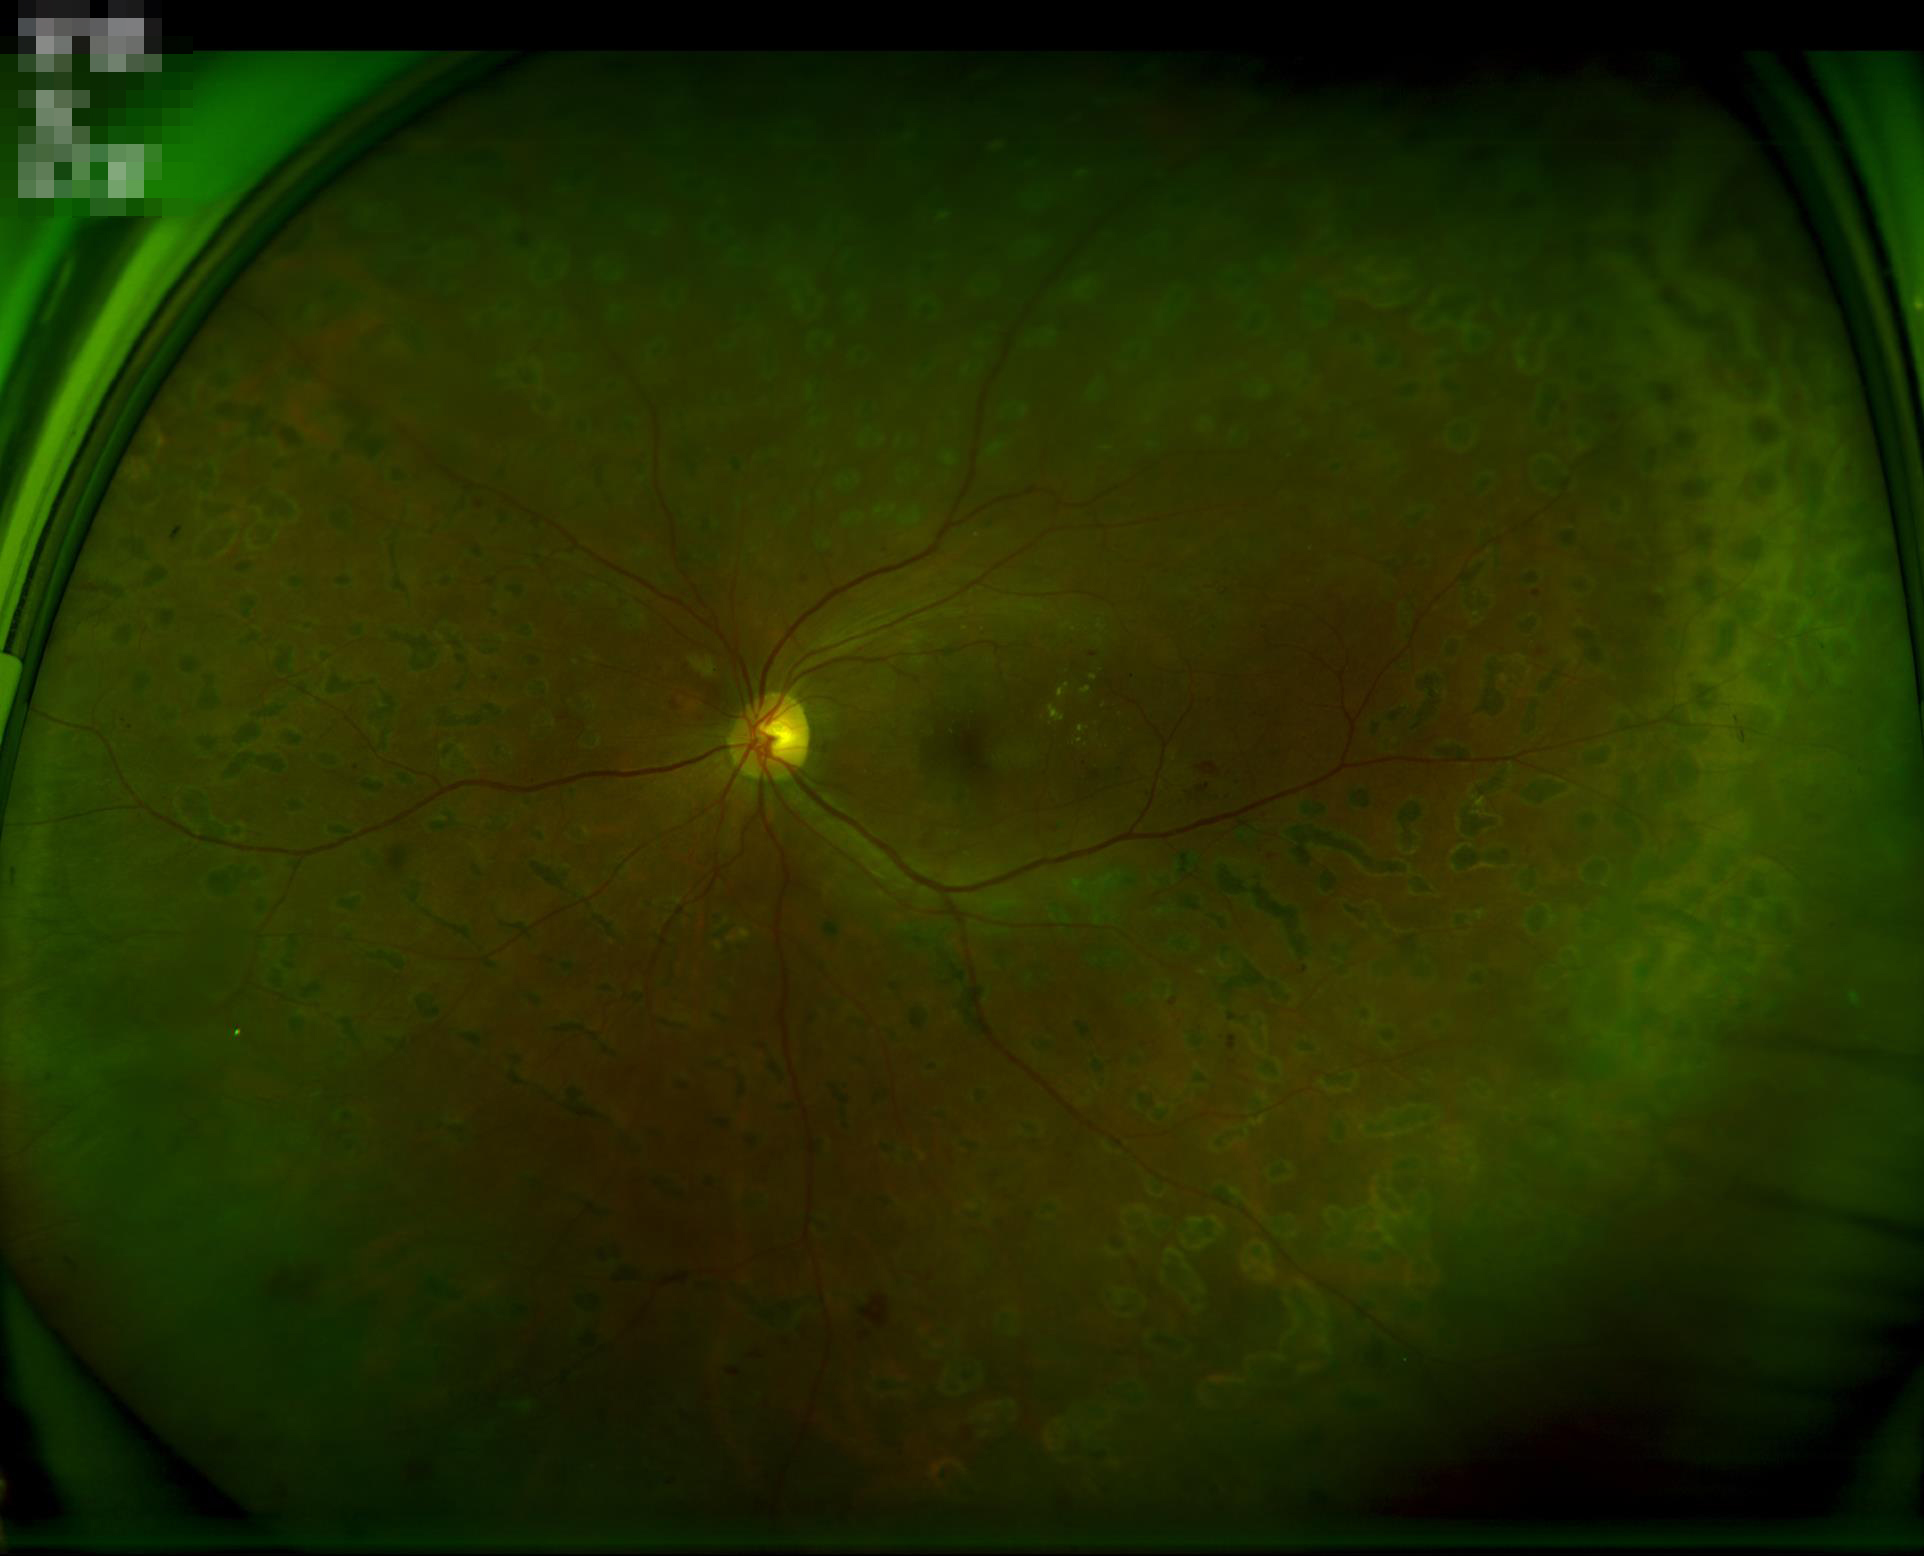 Good dynamic range. Illumination and color balance are good. Overall image quality is good. No noticeable blur.